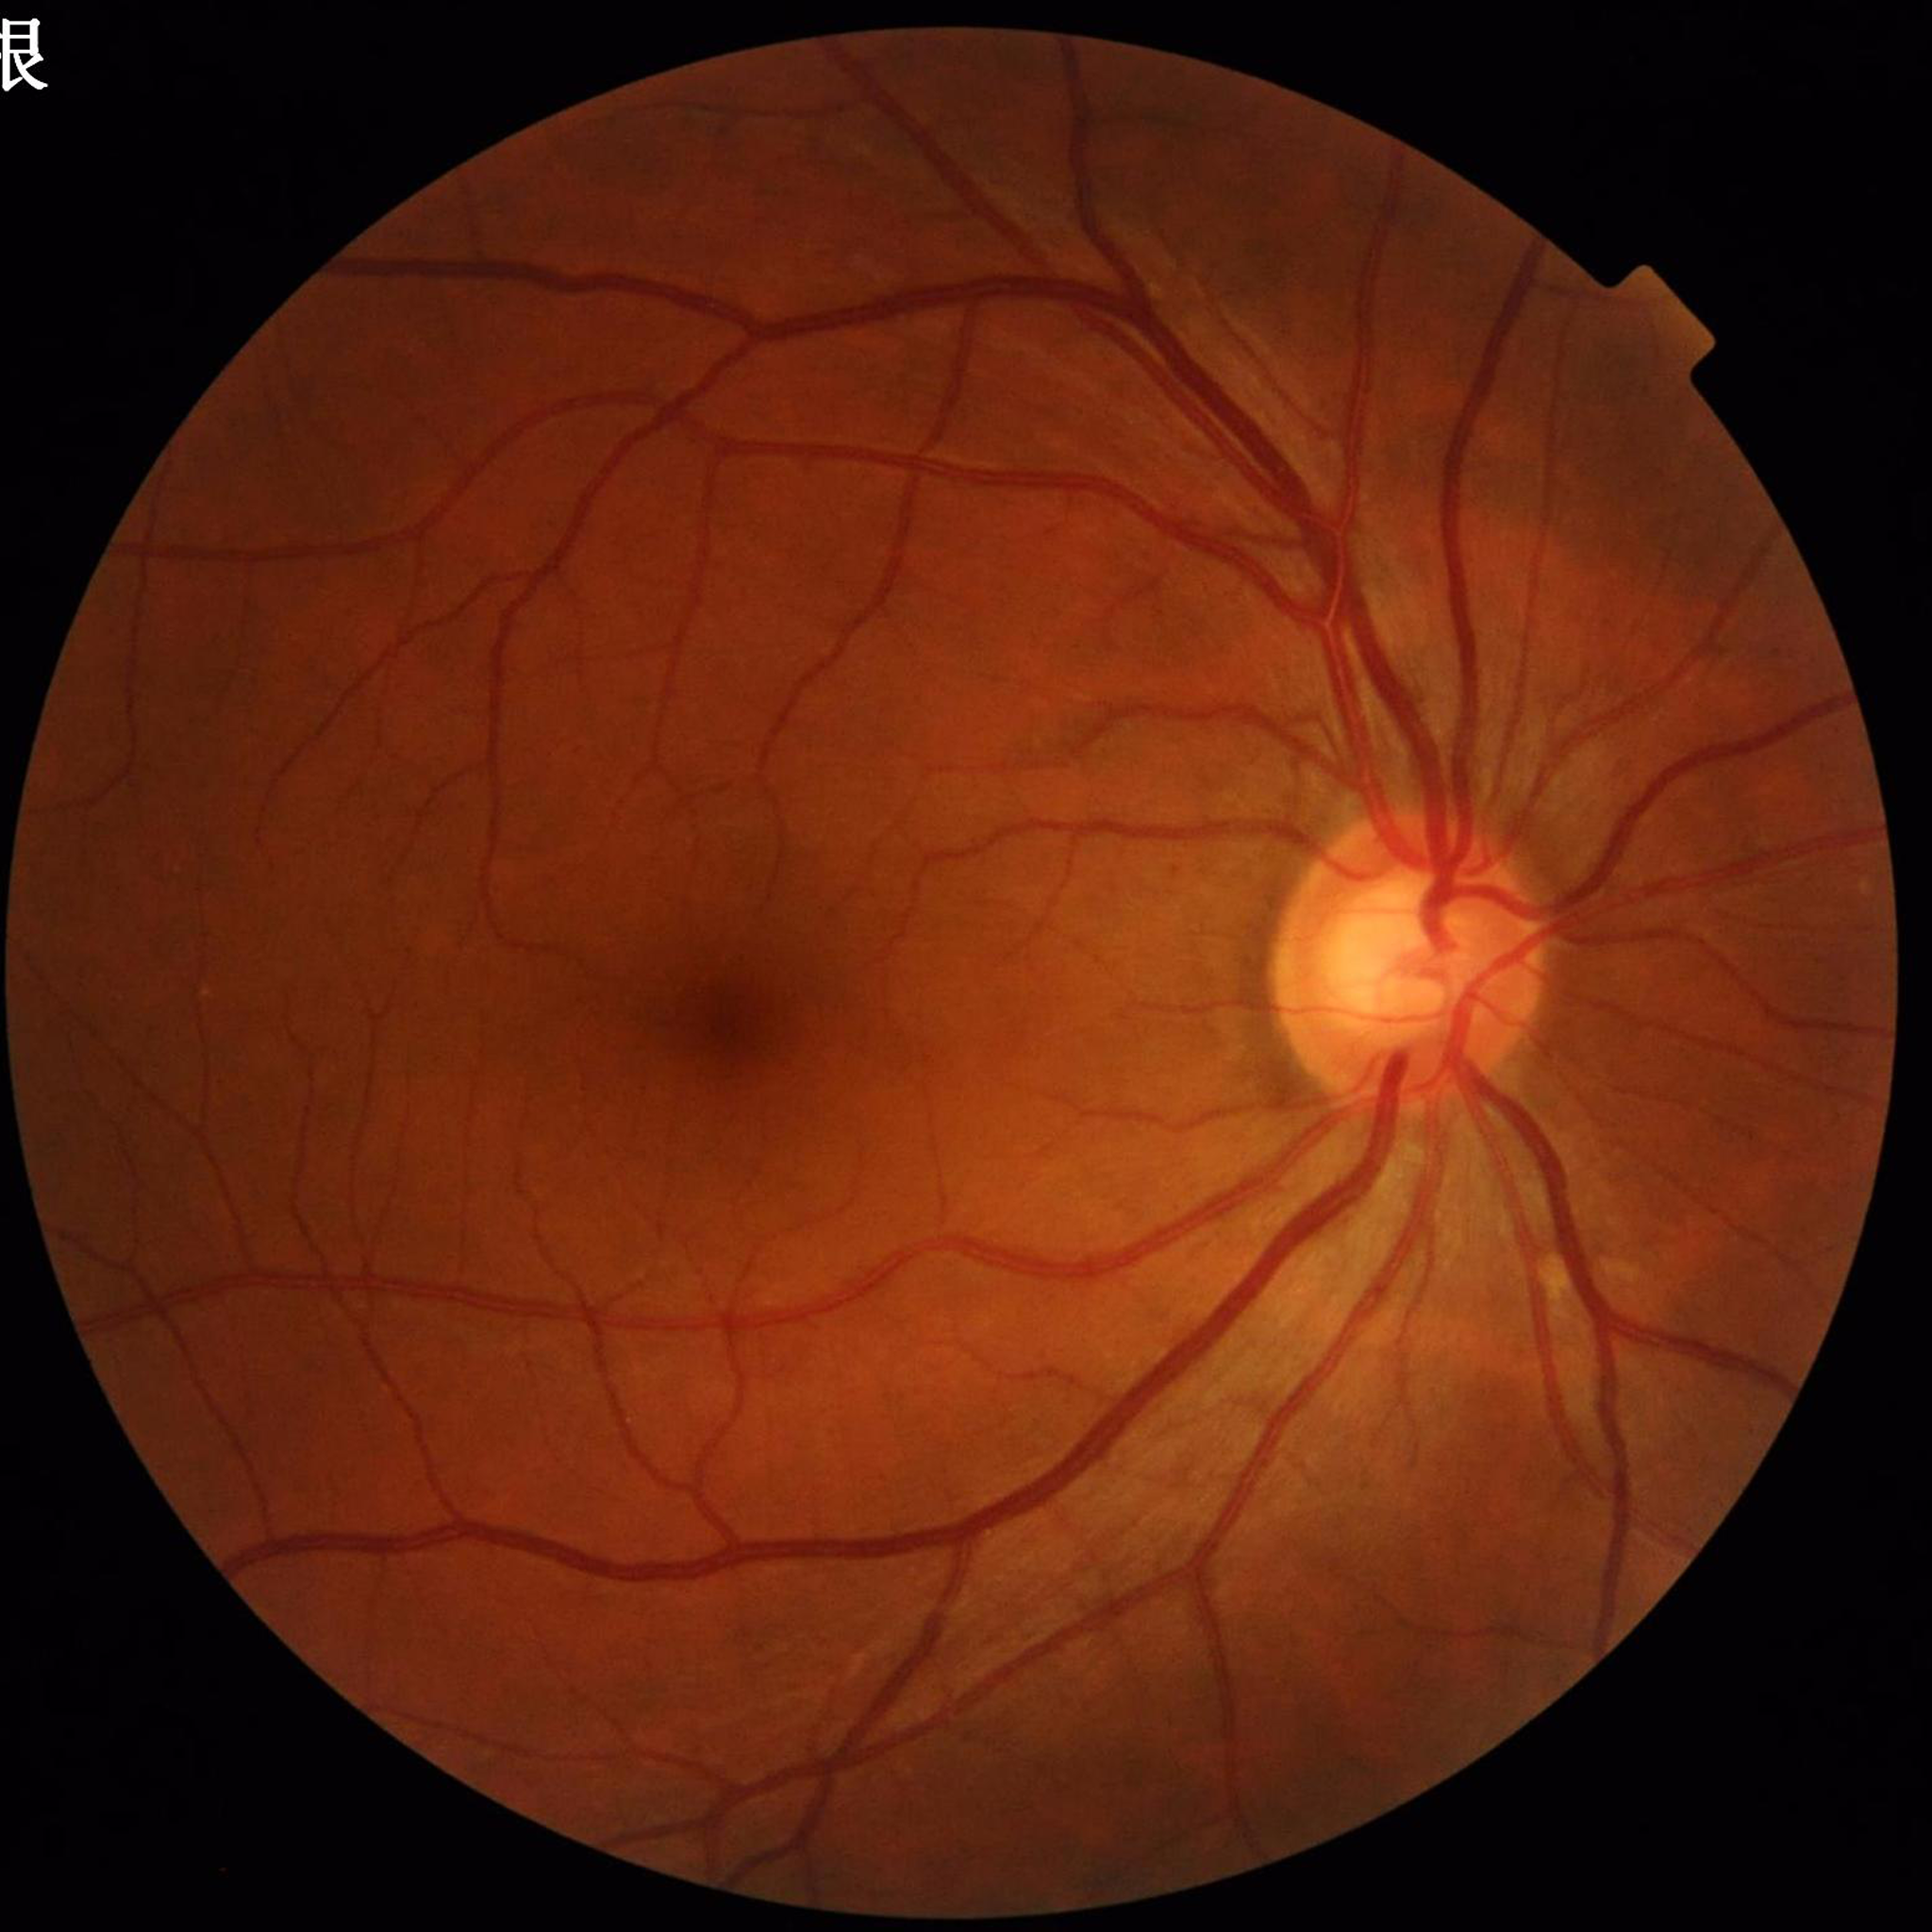 Color fundus photograph from a patient diagnosed with glaucoma.